Color fundus image, 45° field of view, 1932 by 1916 pixels — 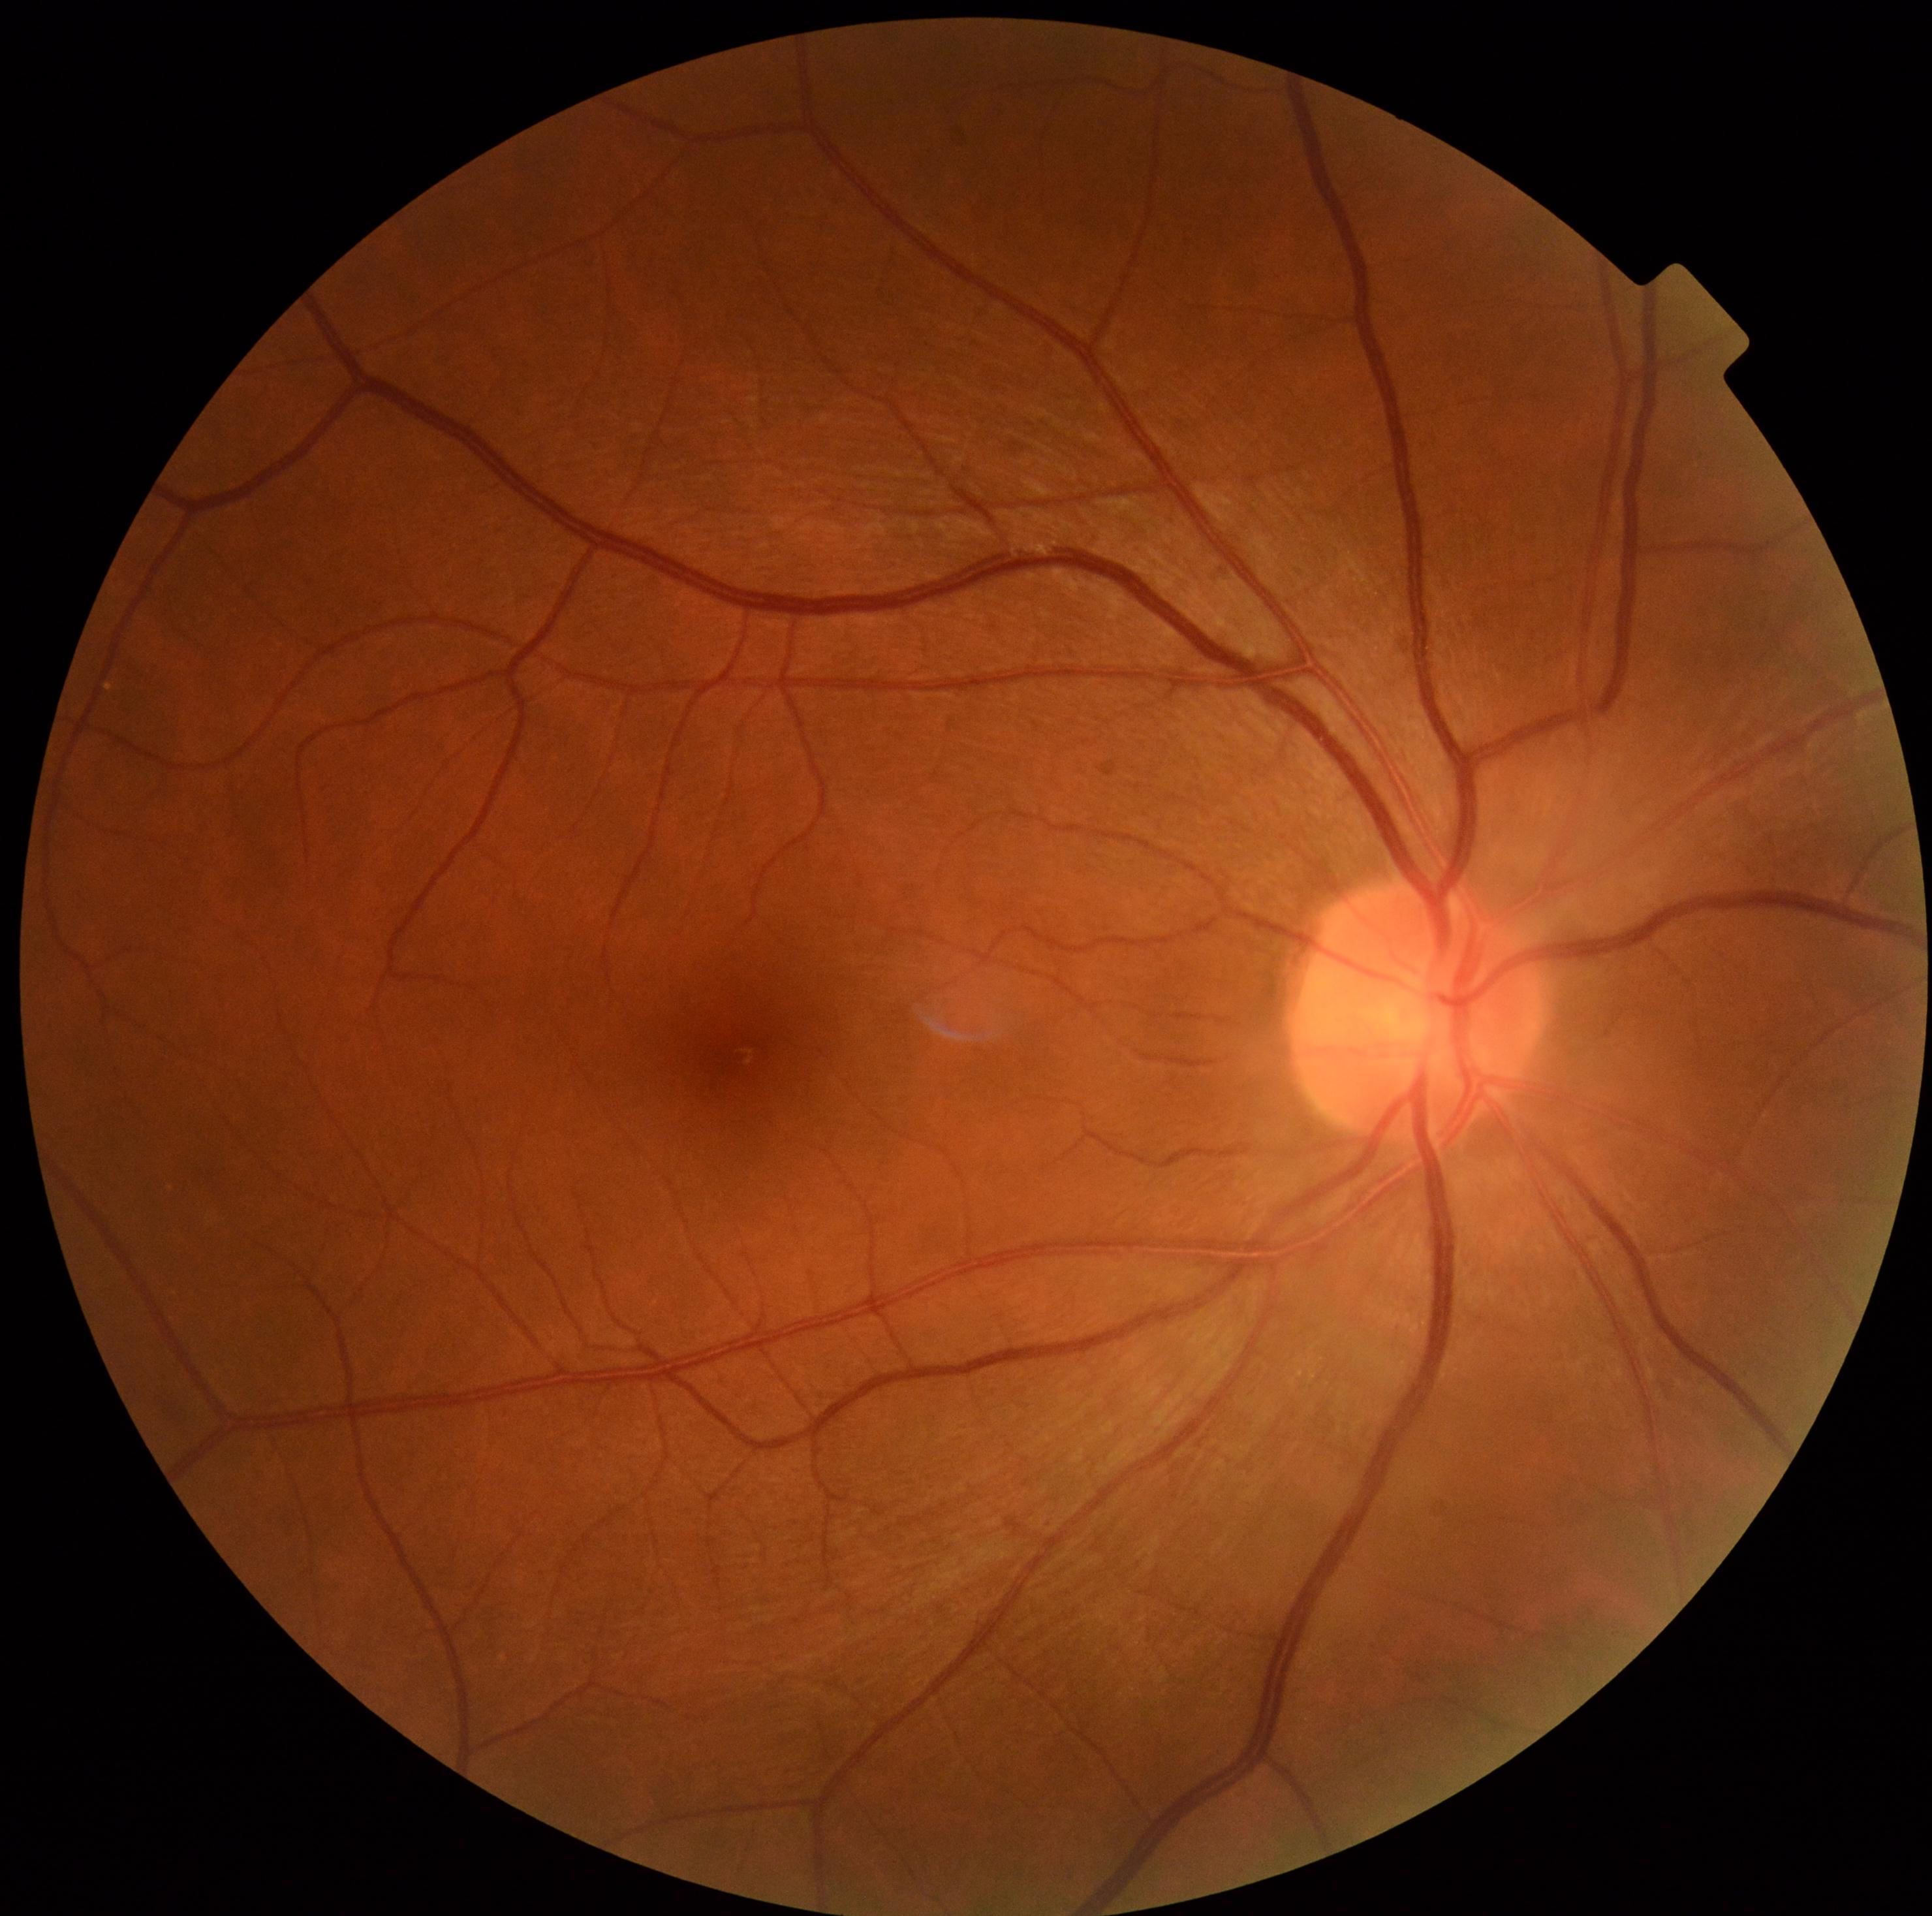 Retinopathy grade: no apparent retinopathy (0) — no visible signs of diabetic retinopathy.